DR severity per modified Davis staging:
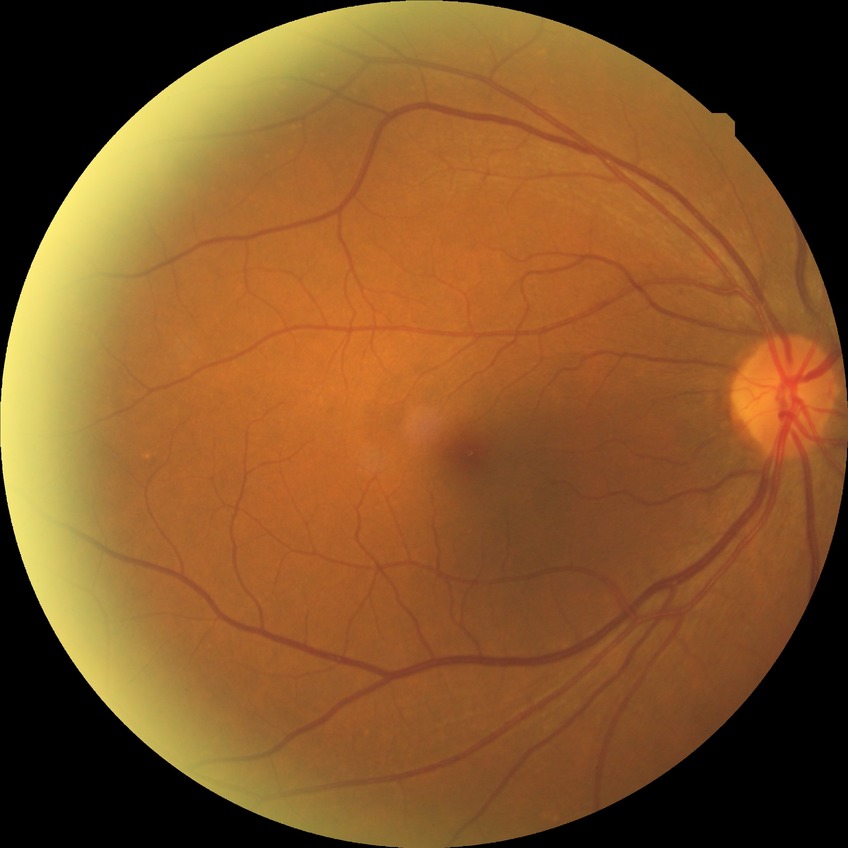

davis_grade: no diabetic retinopathy (NDR)